FOV: 45 degrees.
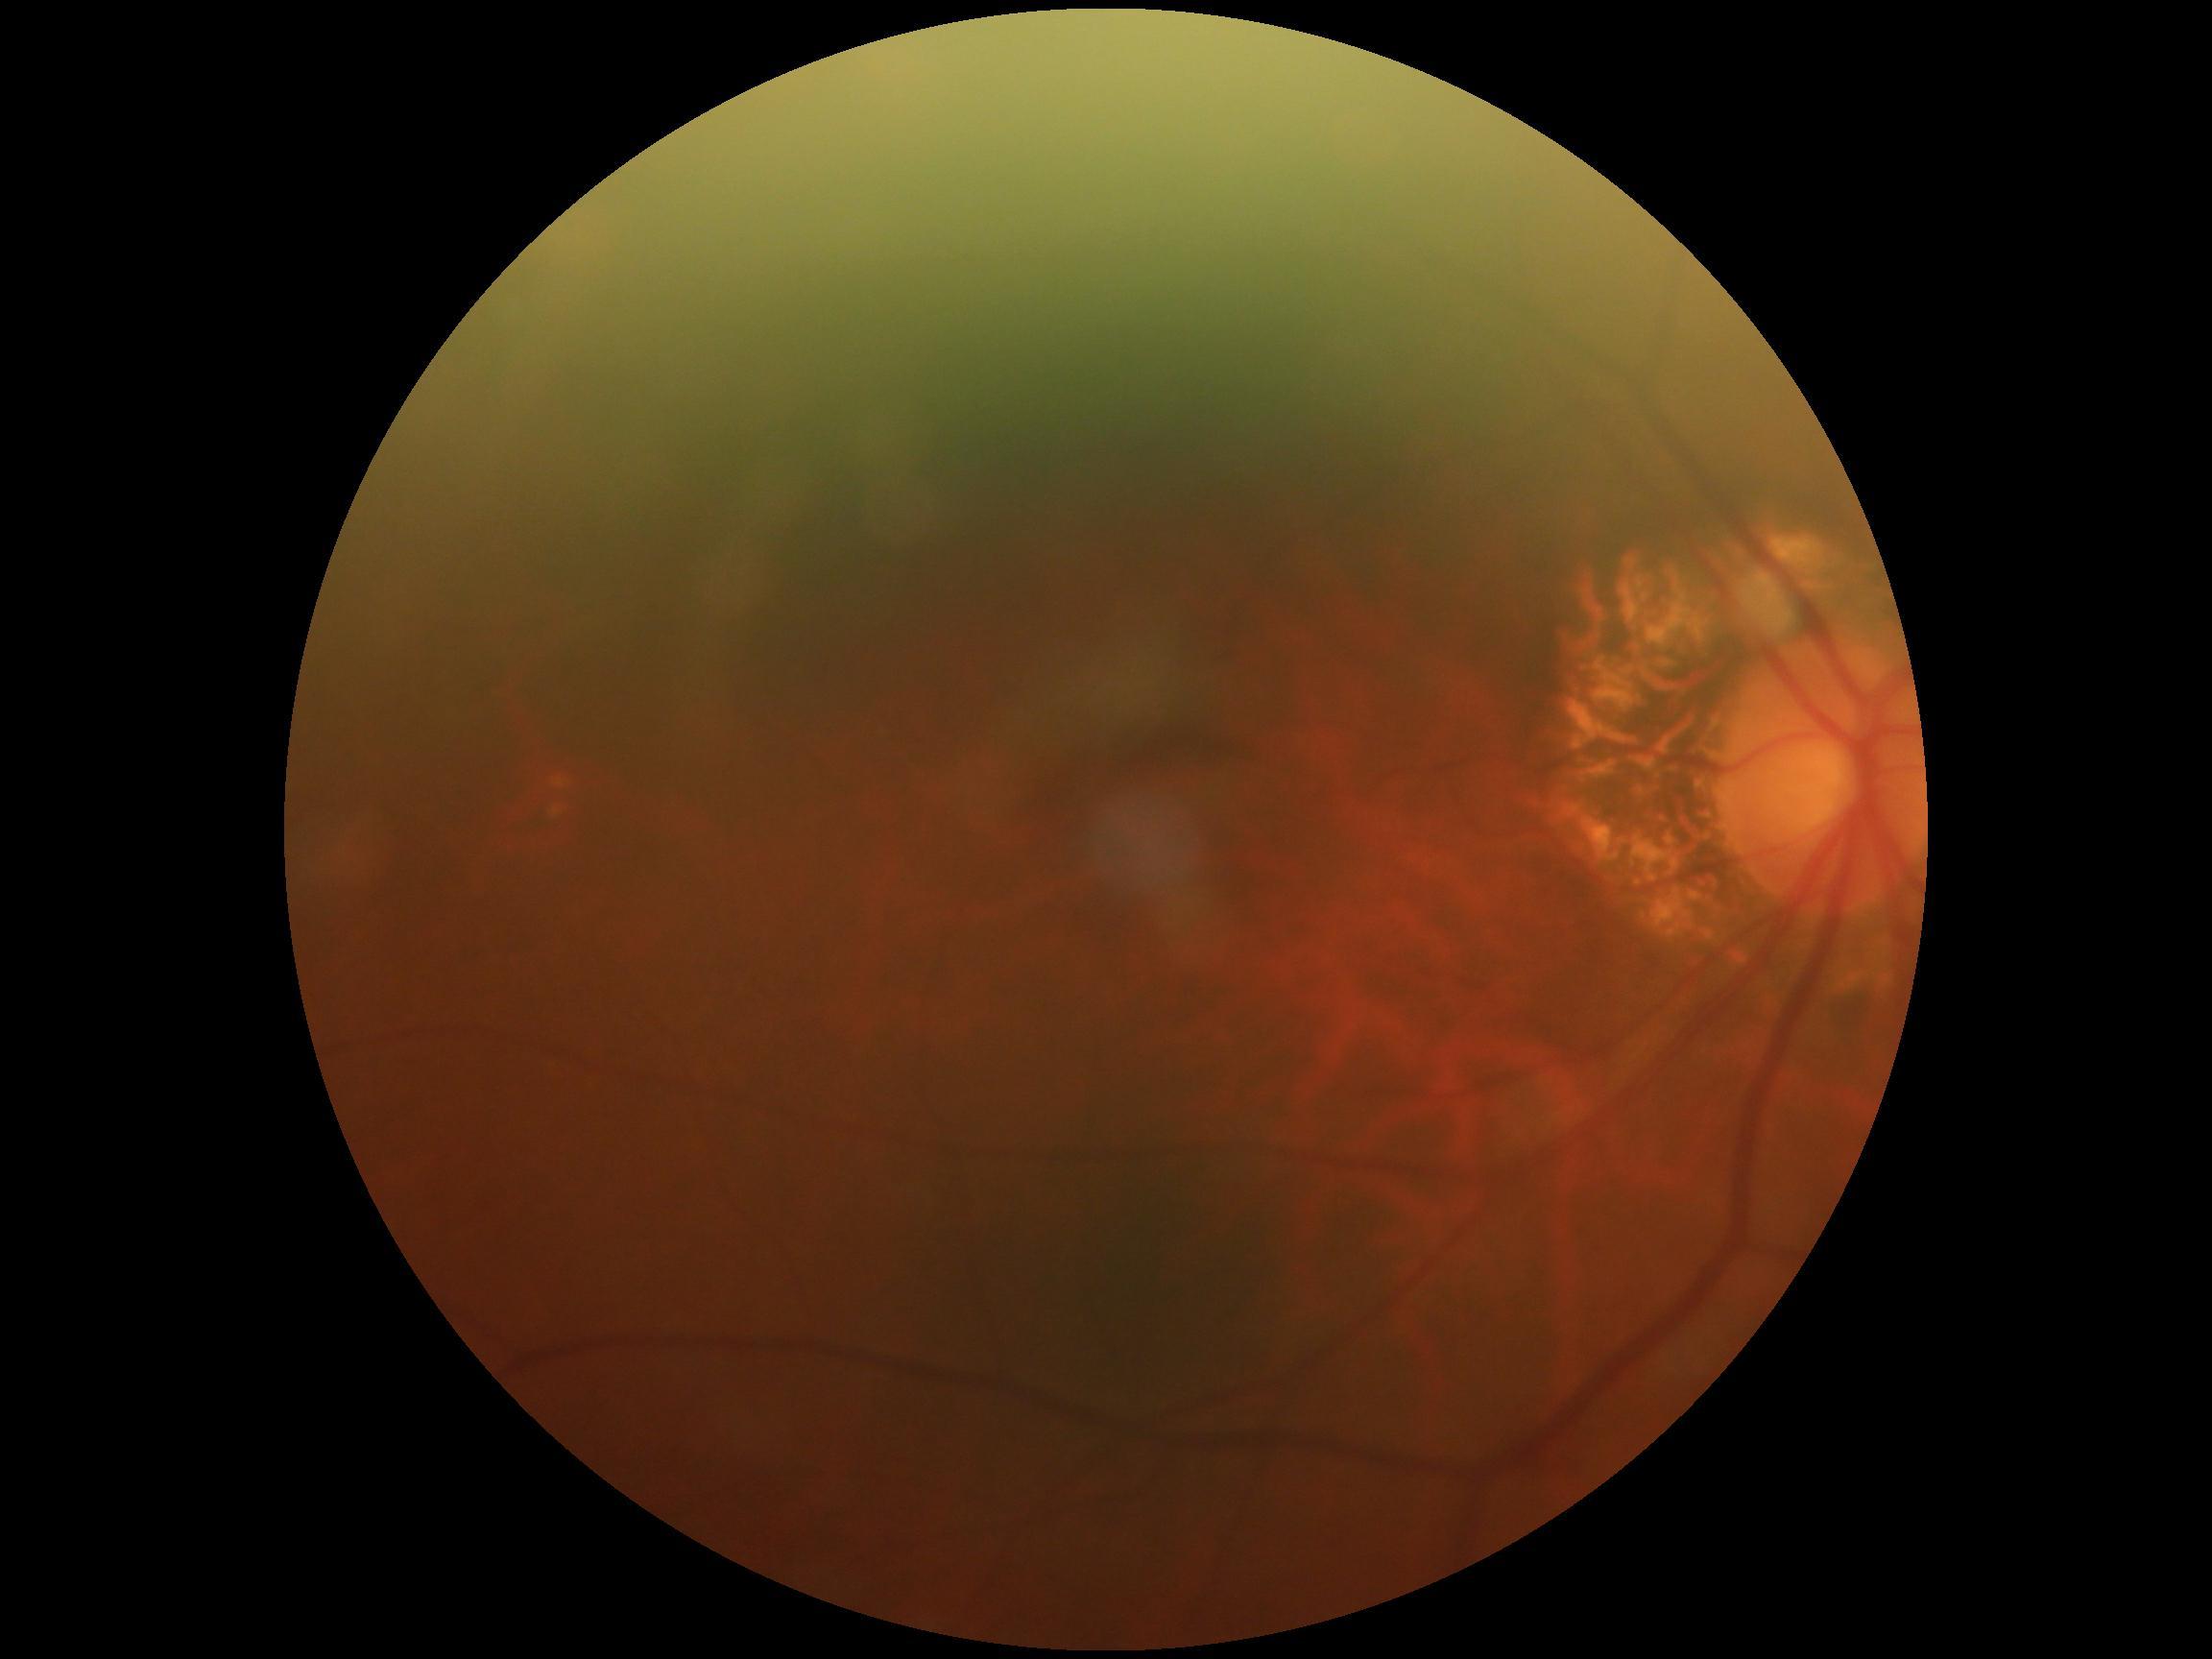
diabetic retinopathy: 0.